Color fundus image · 848x848px · no pharmacologic dilation · NIDEK AFC-230.
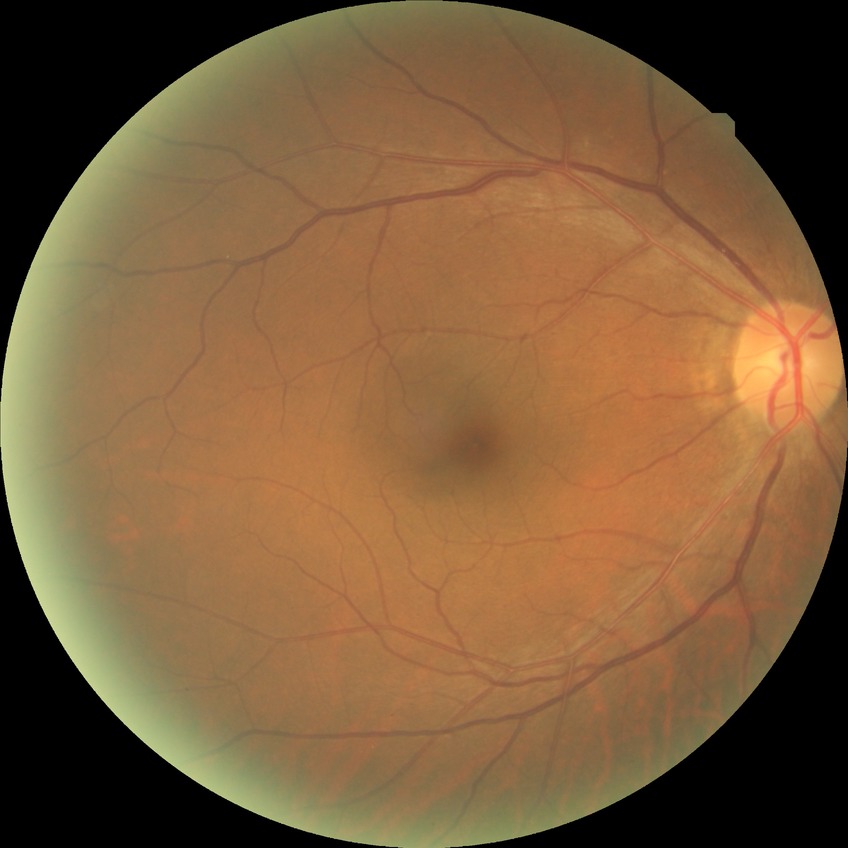

Diabetic retinopathy stage is no diabetic retinopathy.